Pediatric retinal photograph (wide-field).
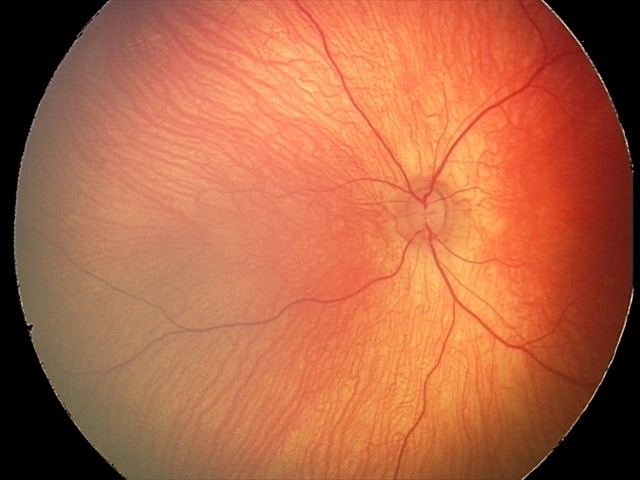 Normal screening examination.